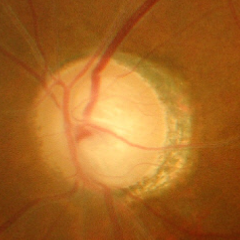

Q: What stage of glaucoma is present?
A: Yes — severe glaucomatous damage.